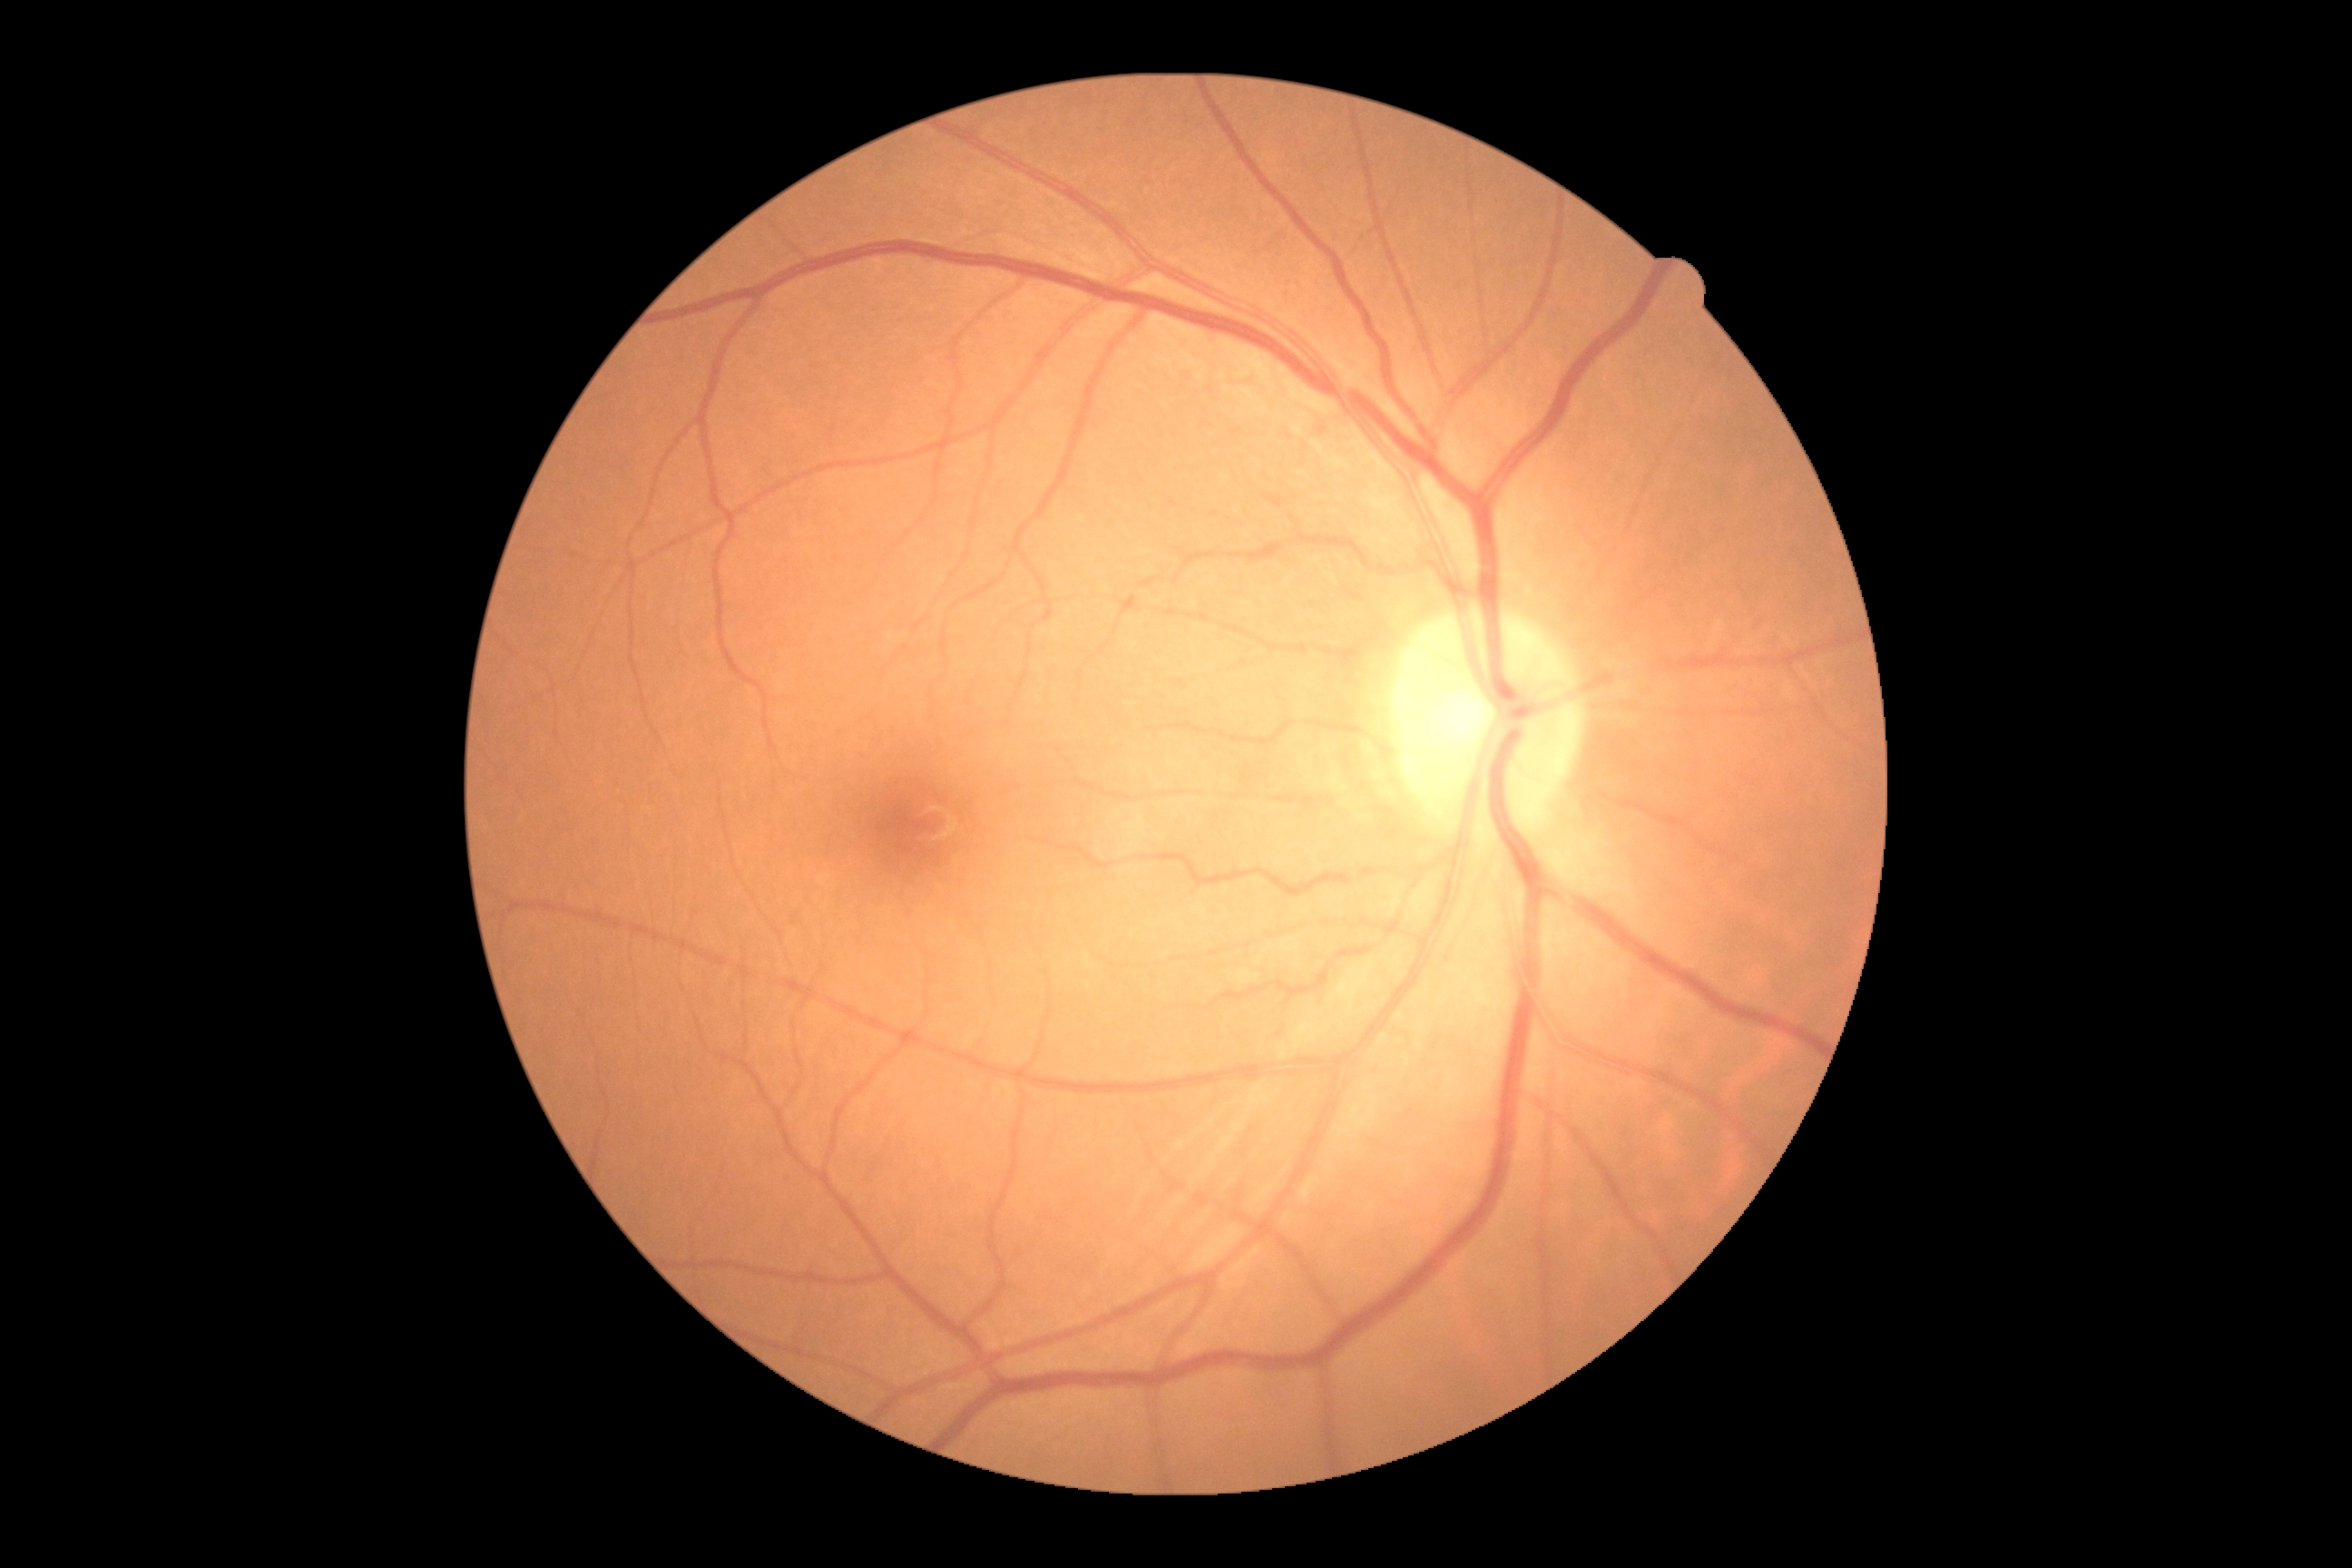
Diabetic retinopathy (DR) is 0.